RetCam wide-field infant fundus image:
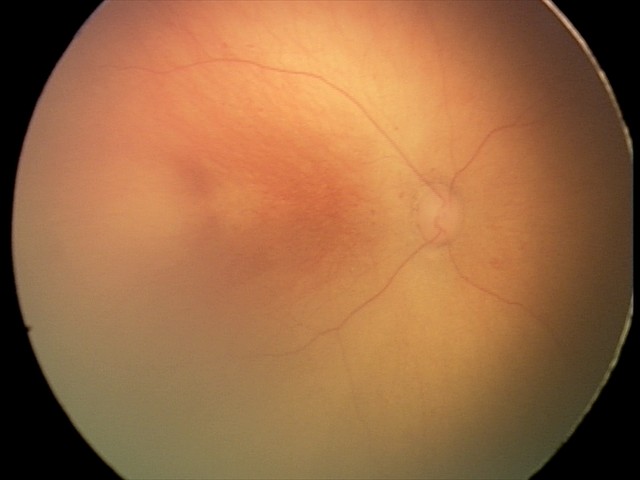
Assessment = ROP stage 0.